Modified Davis classification, nonmydriatic, 848 by 848 pixels.
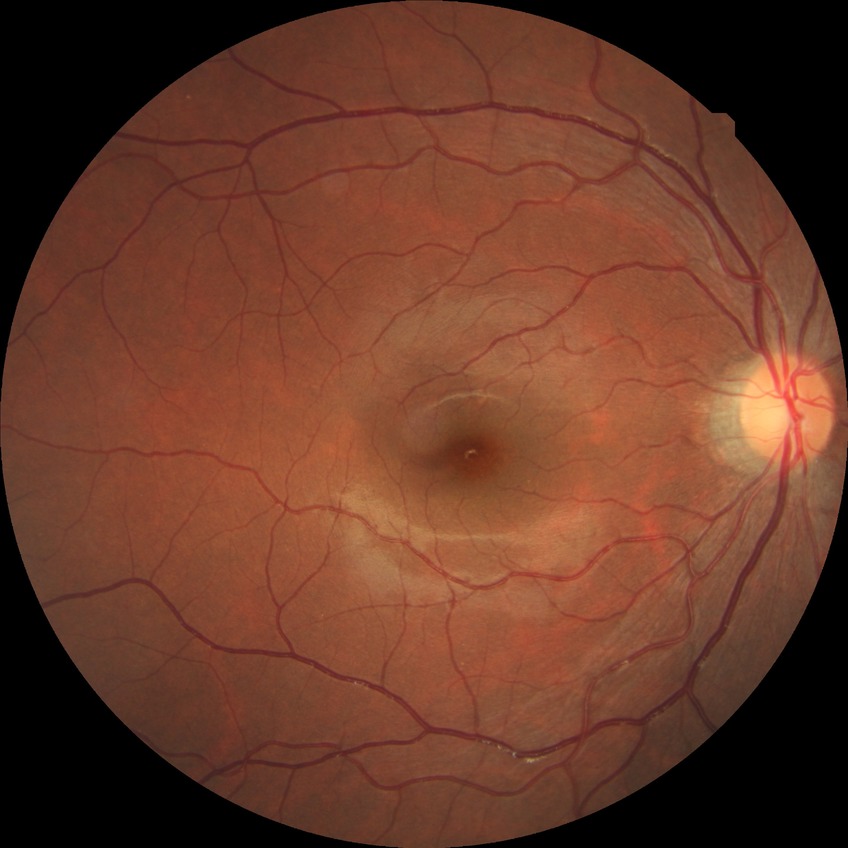 Diabetic retinopathy stage: no diabetic retinopathy.